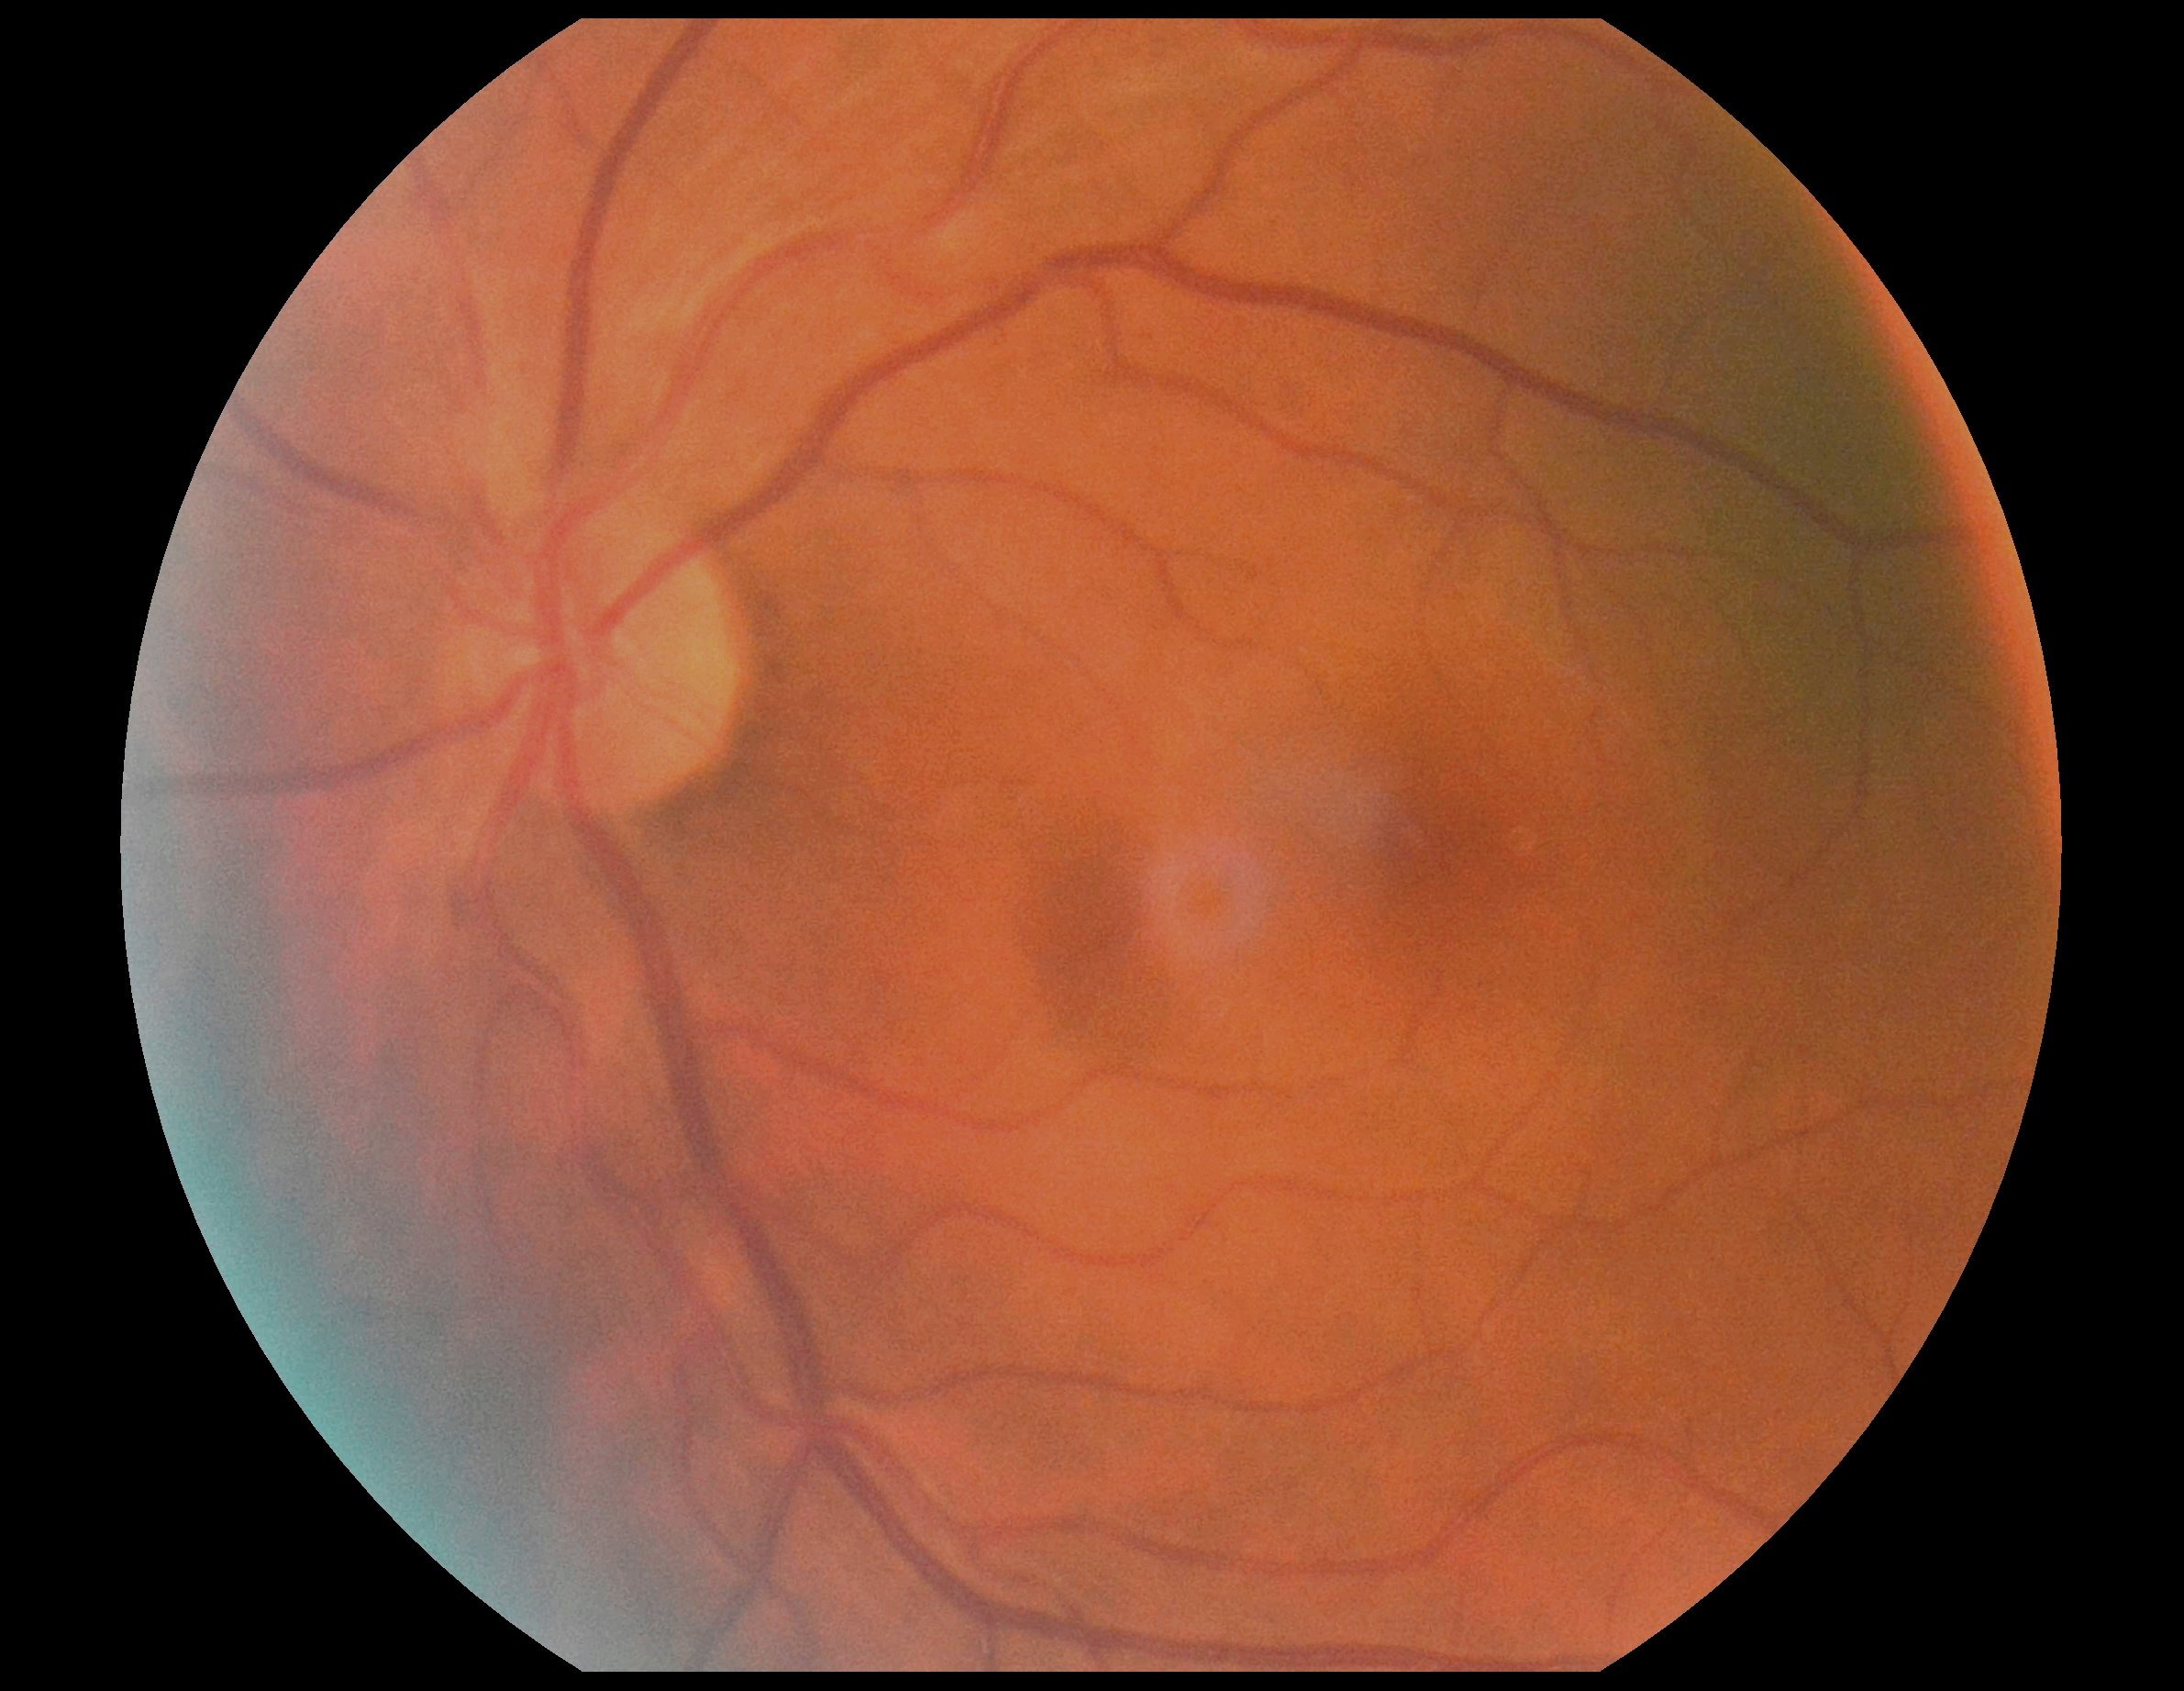 No signs of diabetic retinopathy. DR severity is 0.